Wide-field fundus image from infant ROP screening · 1240 by 1240 pixels
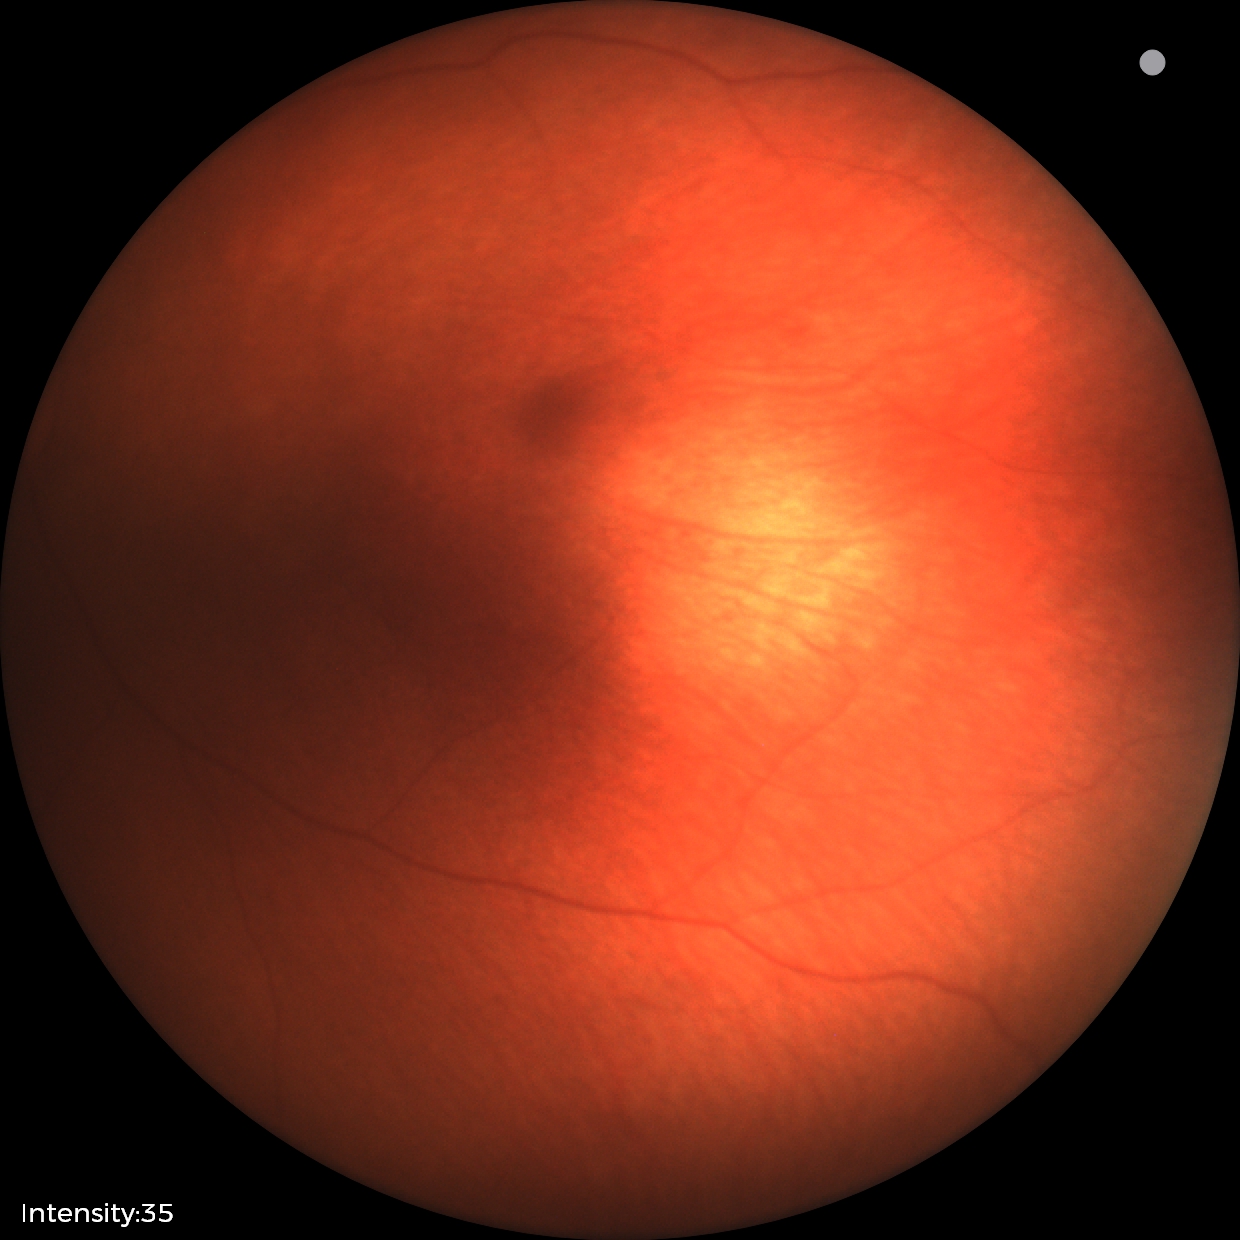
Impression: physiological retinal finding.